848x848px. NIDEK AFC-230. No pharmacologic dilation. 45° FOV.
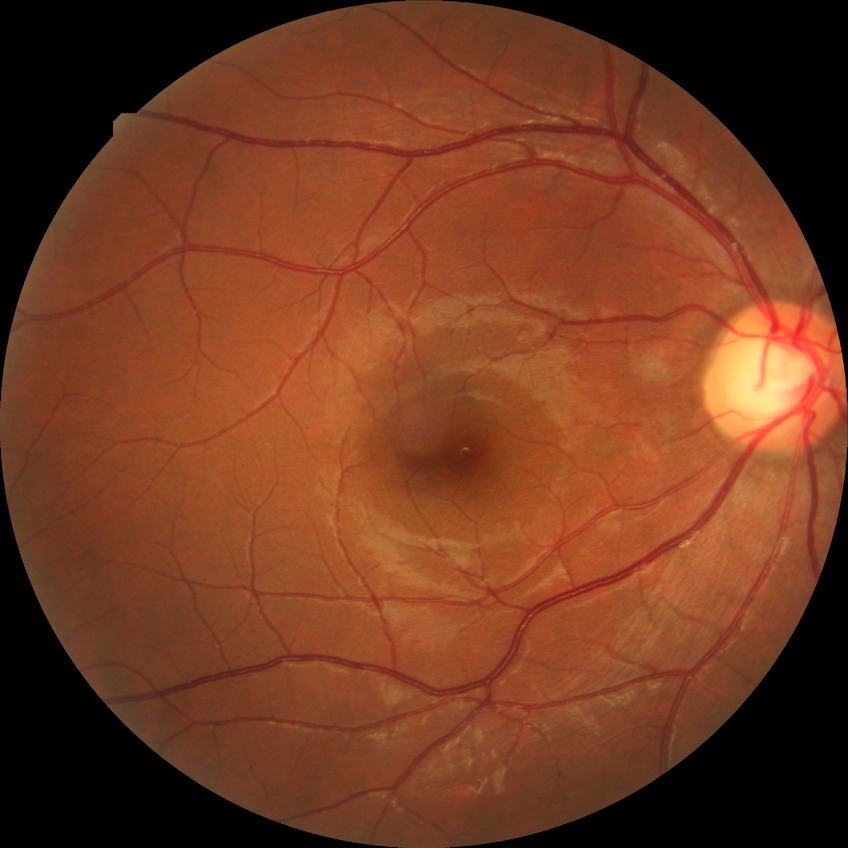
diabetic retinopathy (DR): no diabetic retinopathy (NDR).